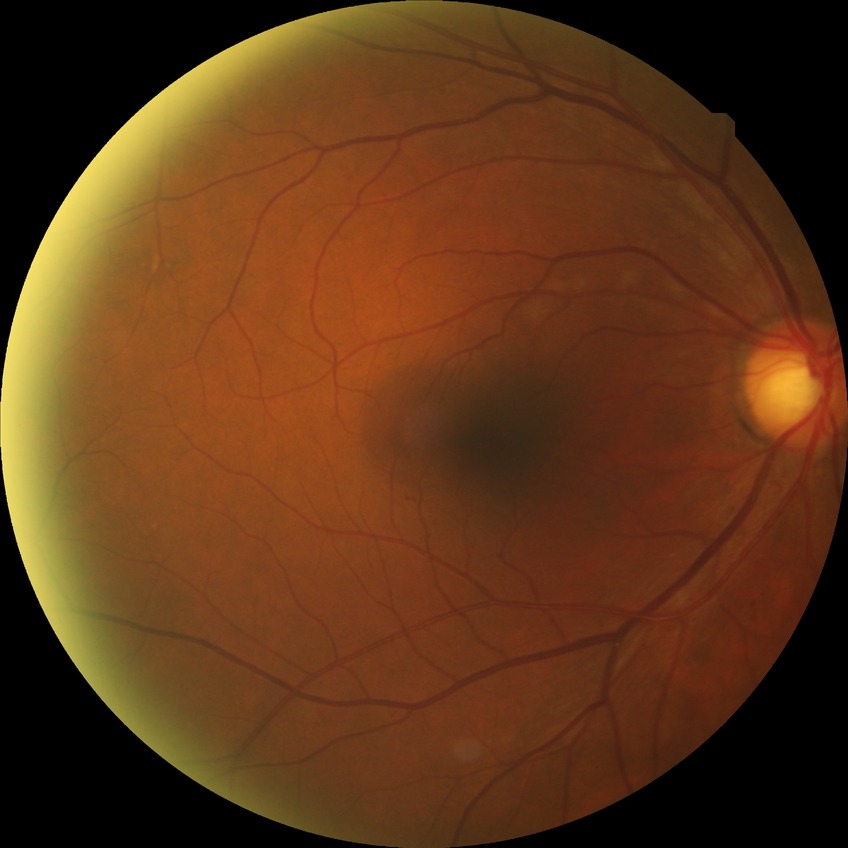 Diabetic retinopathy (DR) is simple diabetic retinopathy (SDR).